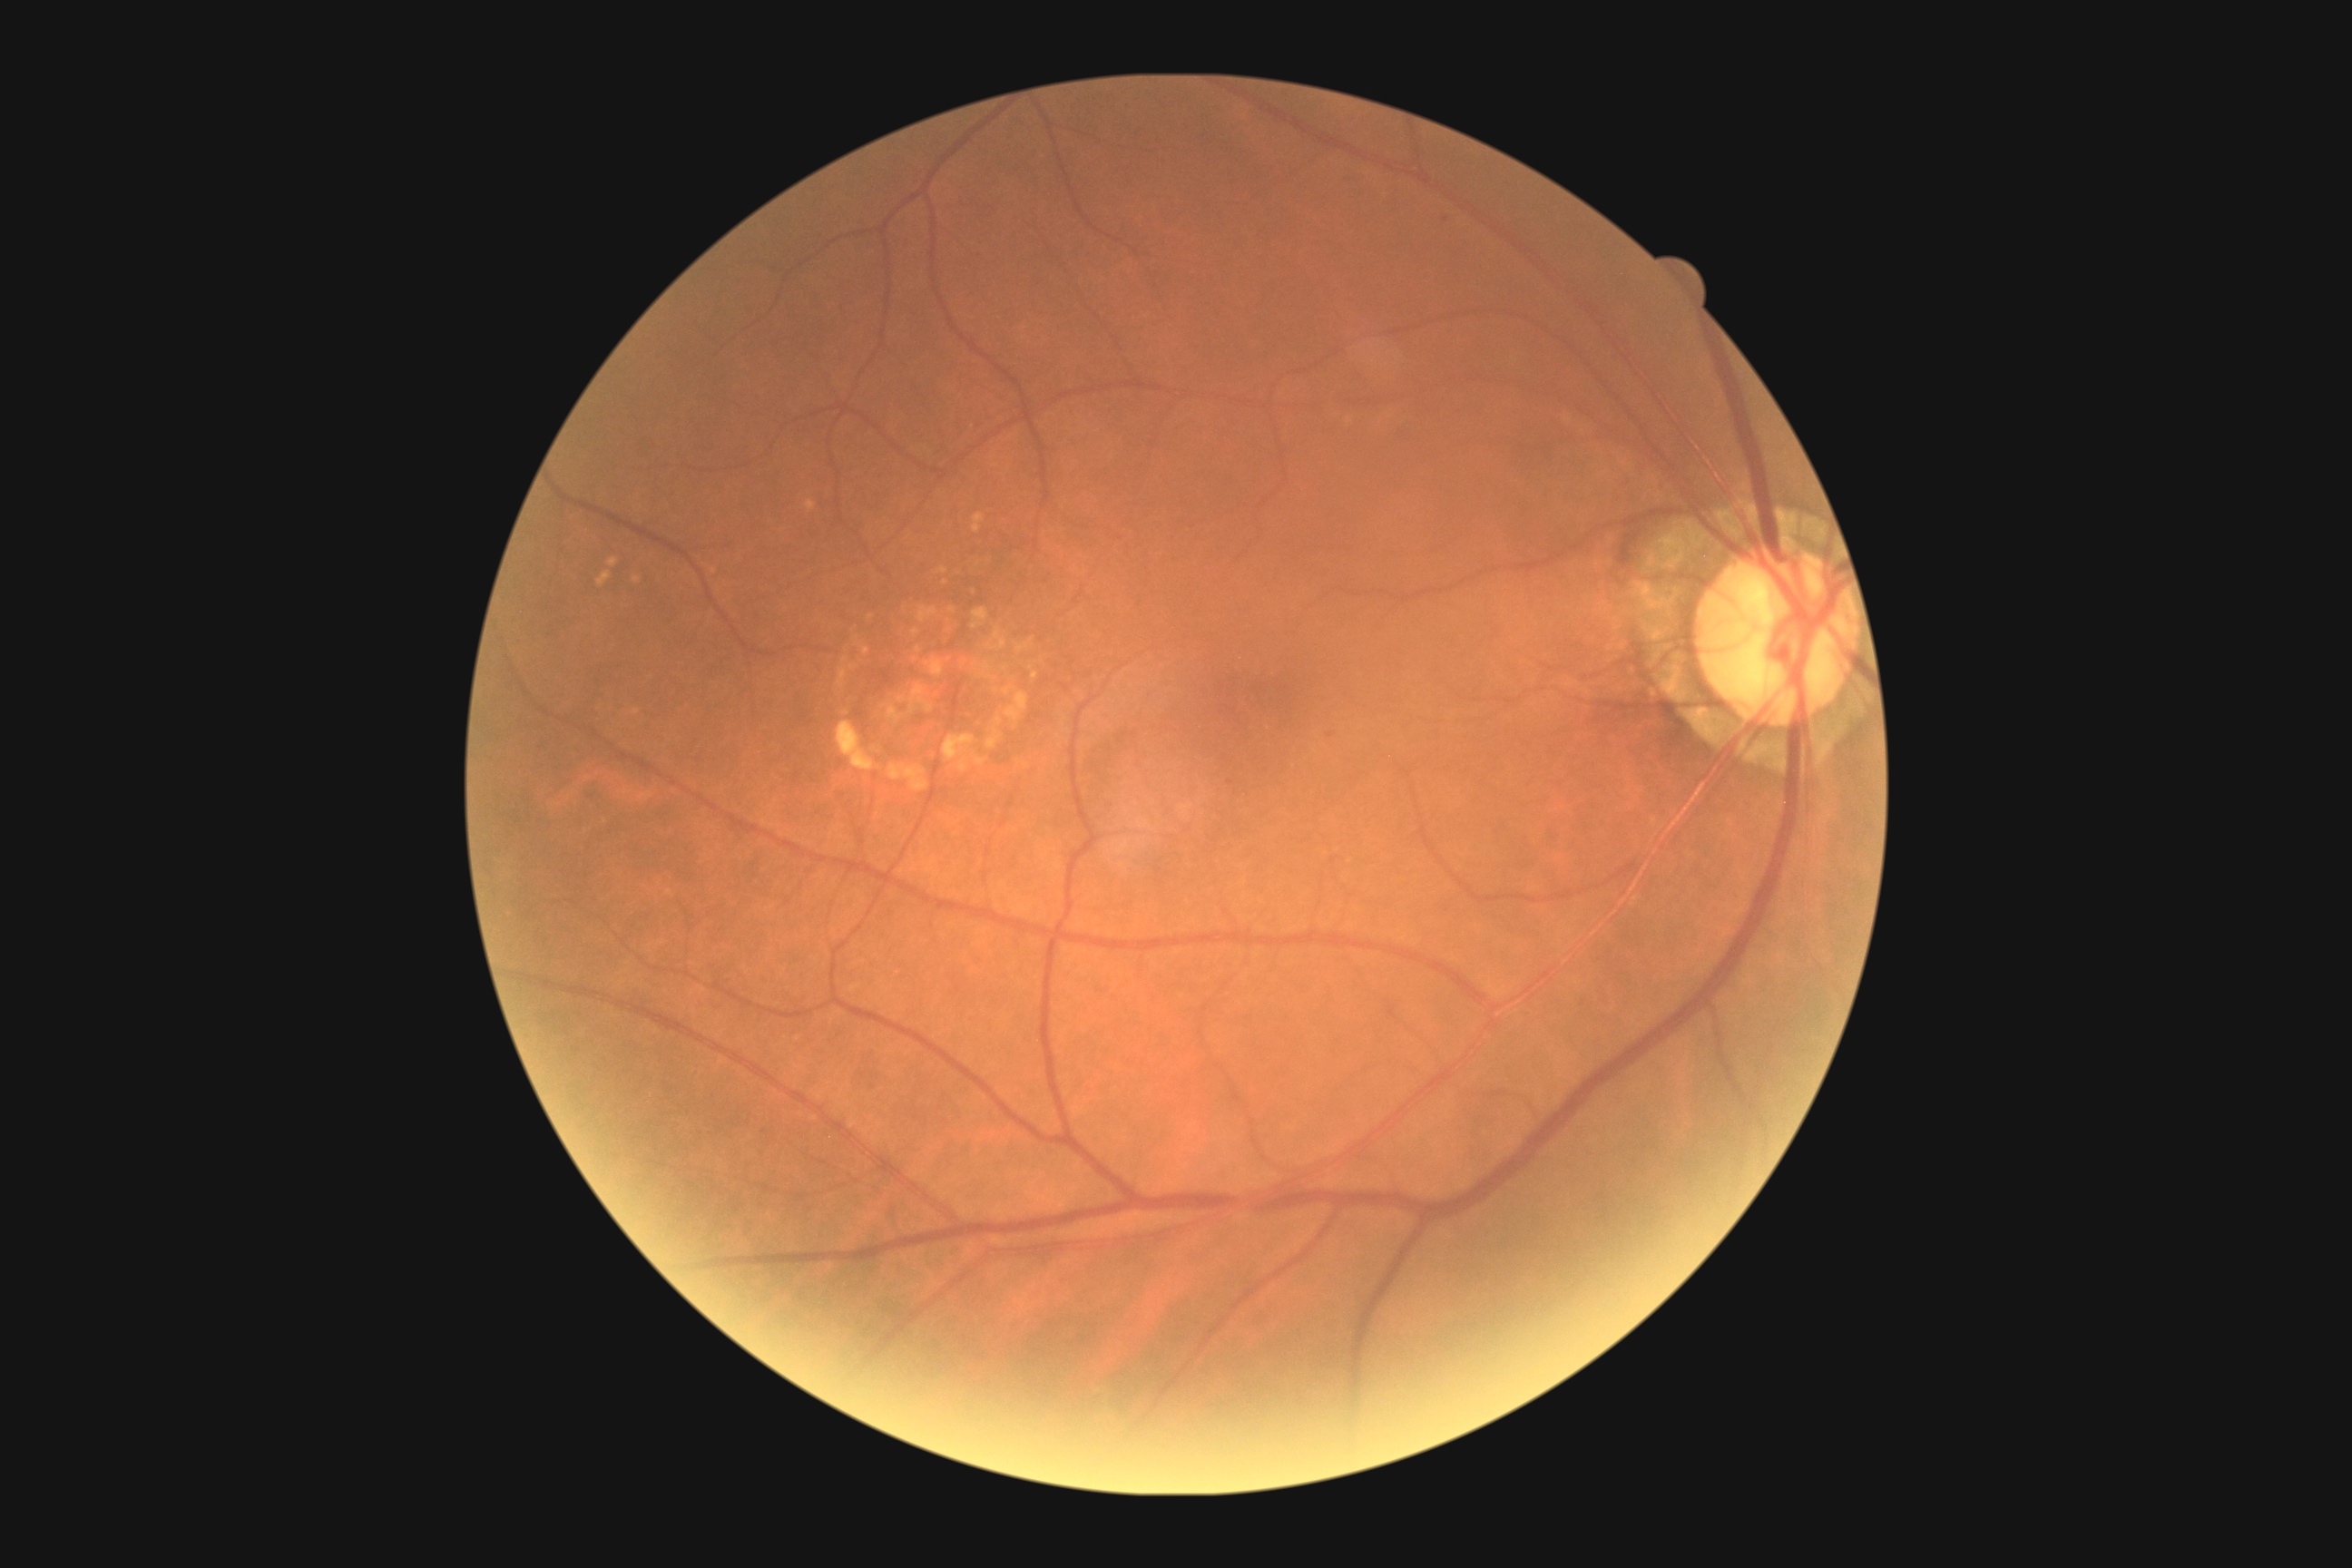
* diabetic retinopathy: mild NPDR (grade 1)